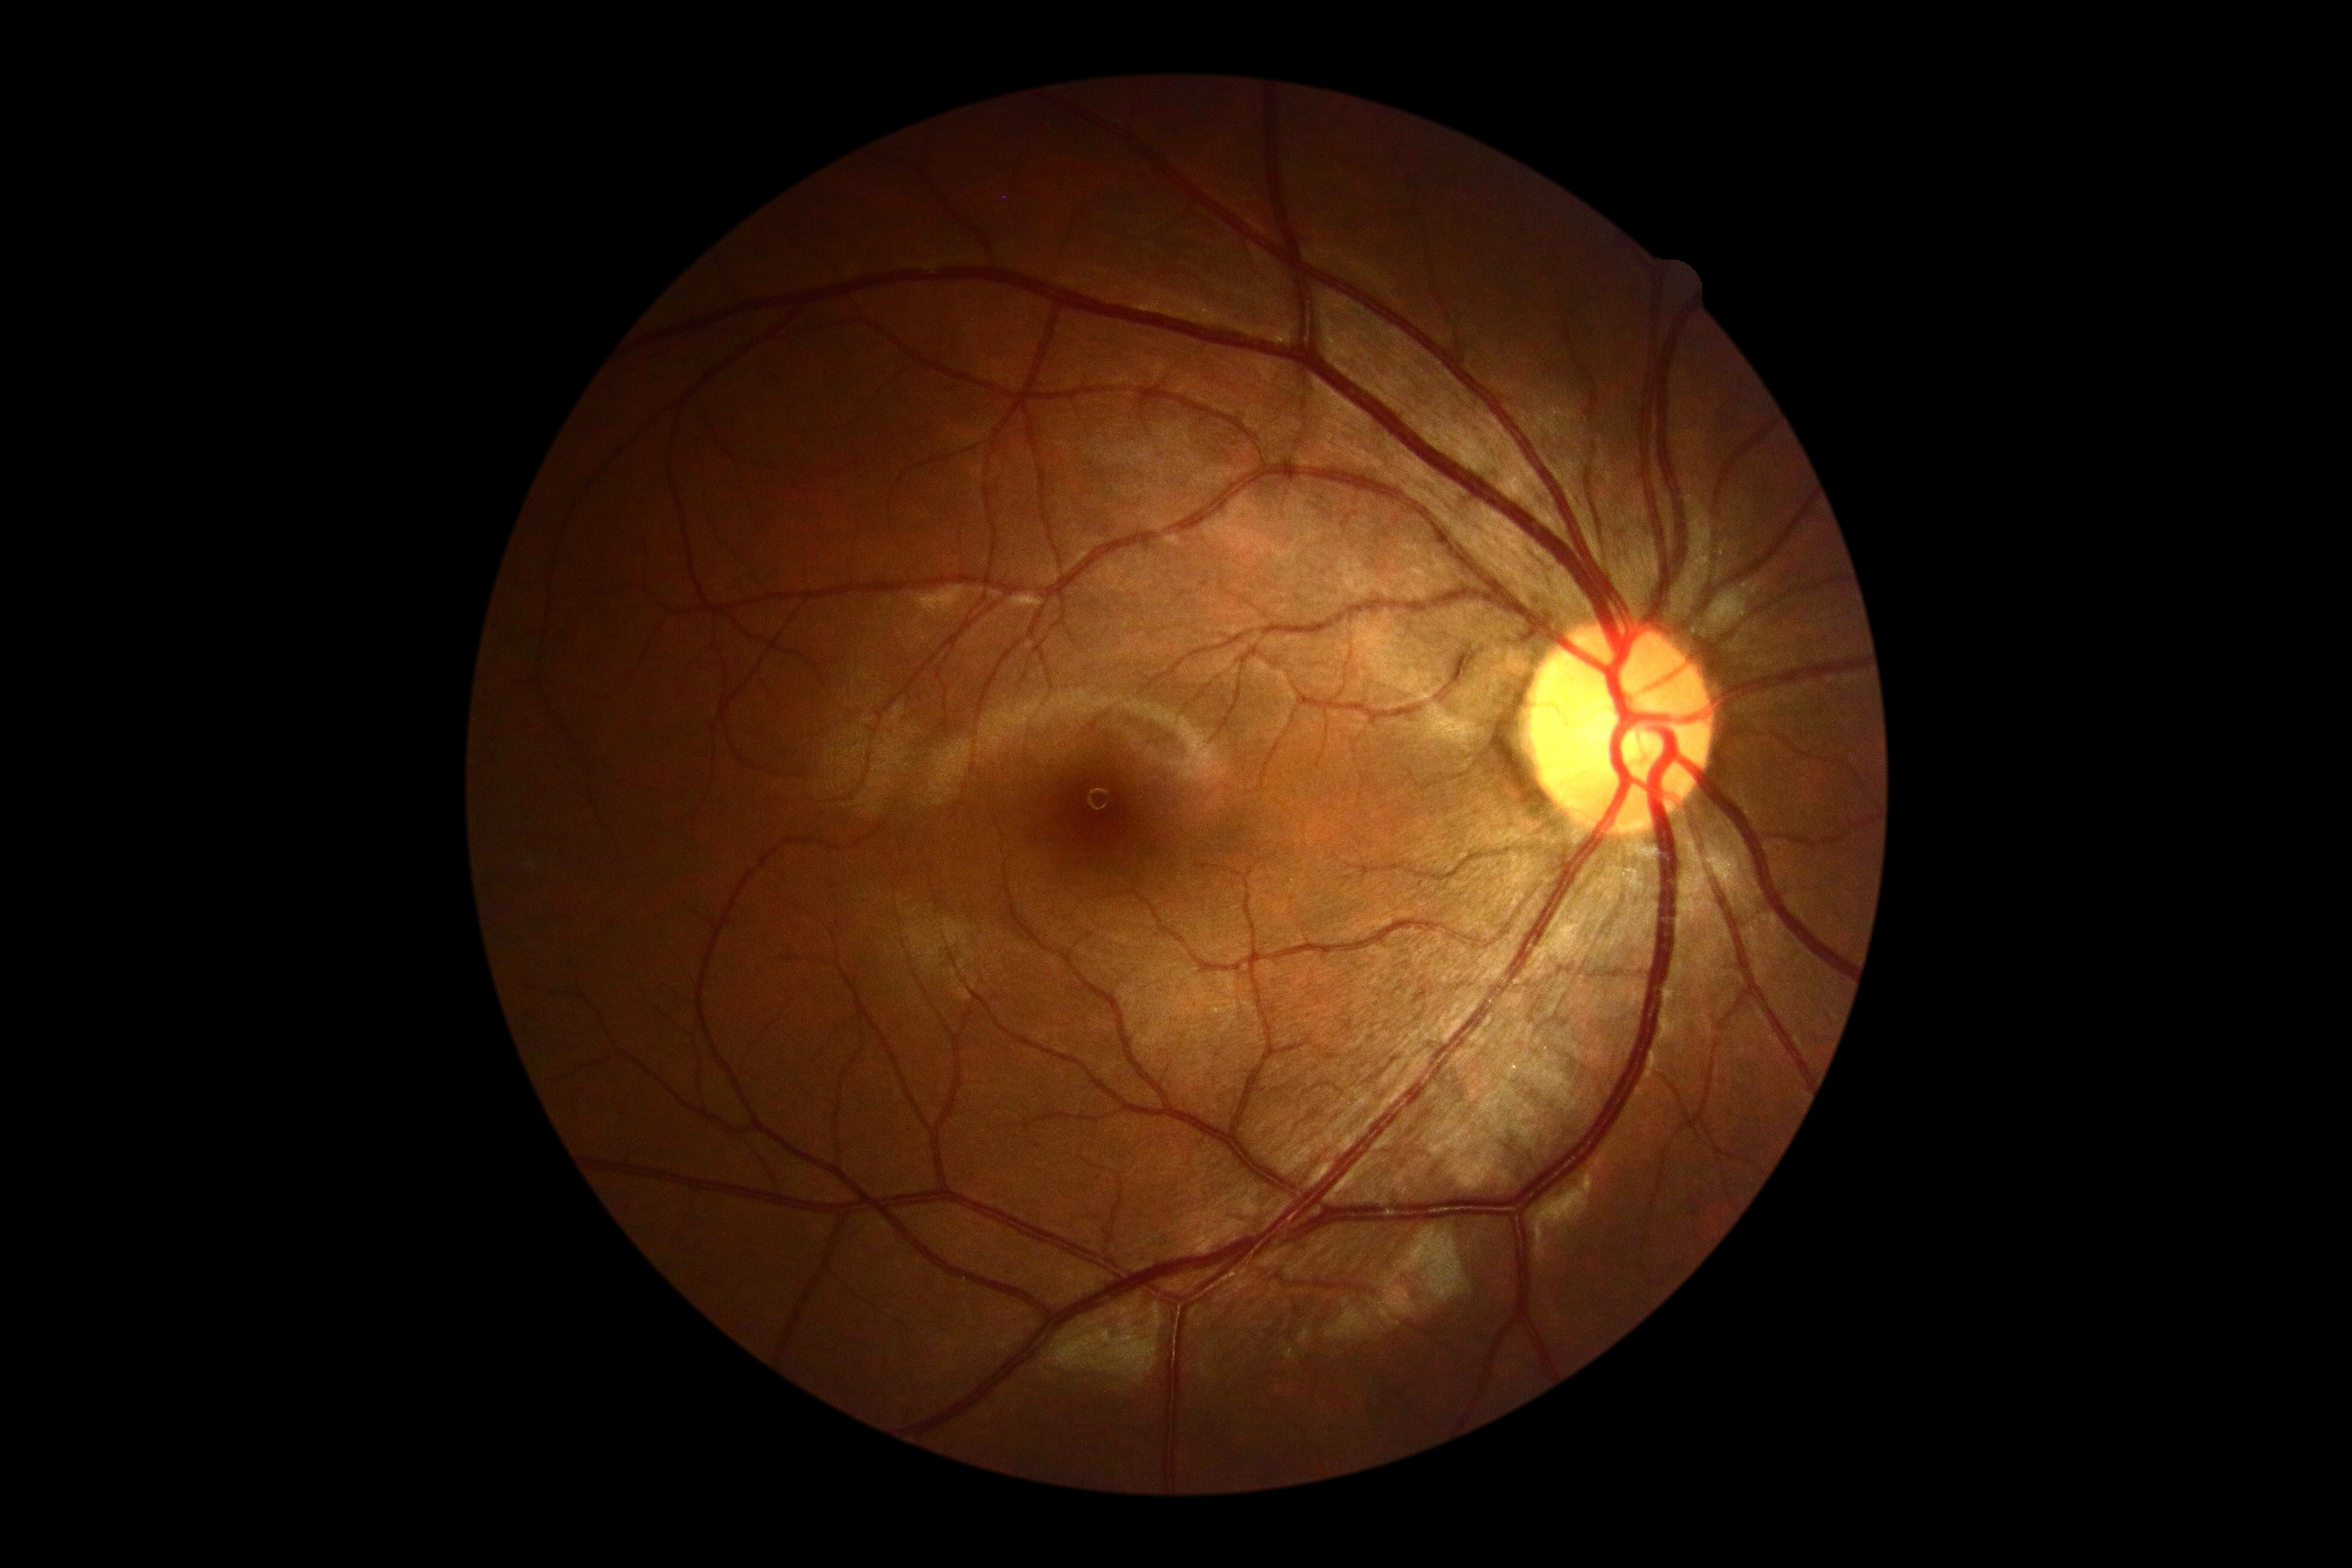 Findings:
• retinopathy grade — 0